Camera: Phoenix ICON (100° FOV). Wide-field fundus image from infant ROP screening — 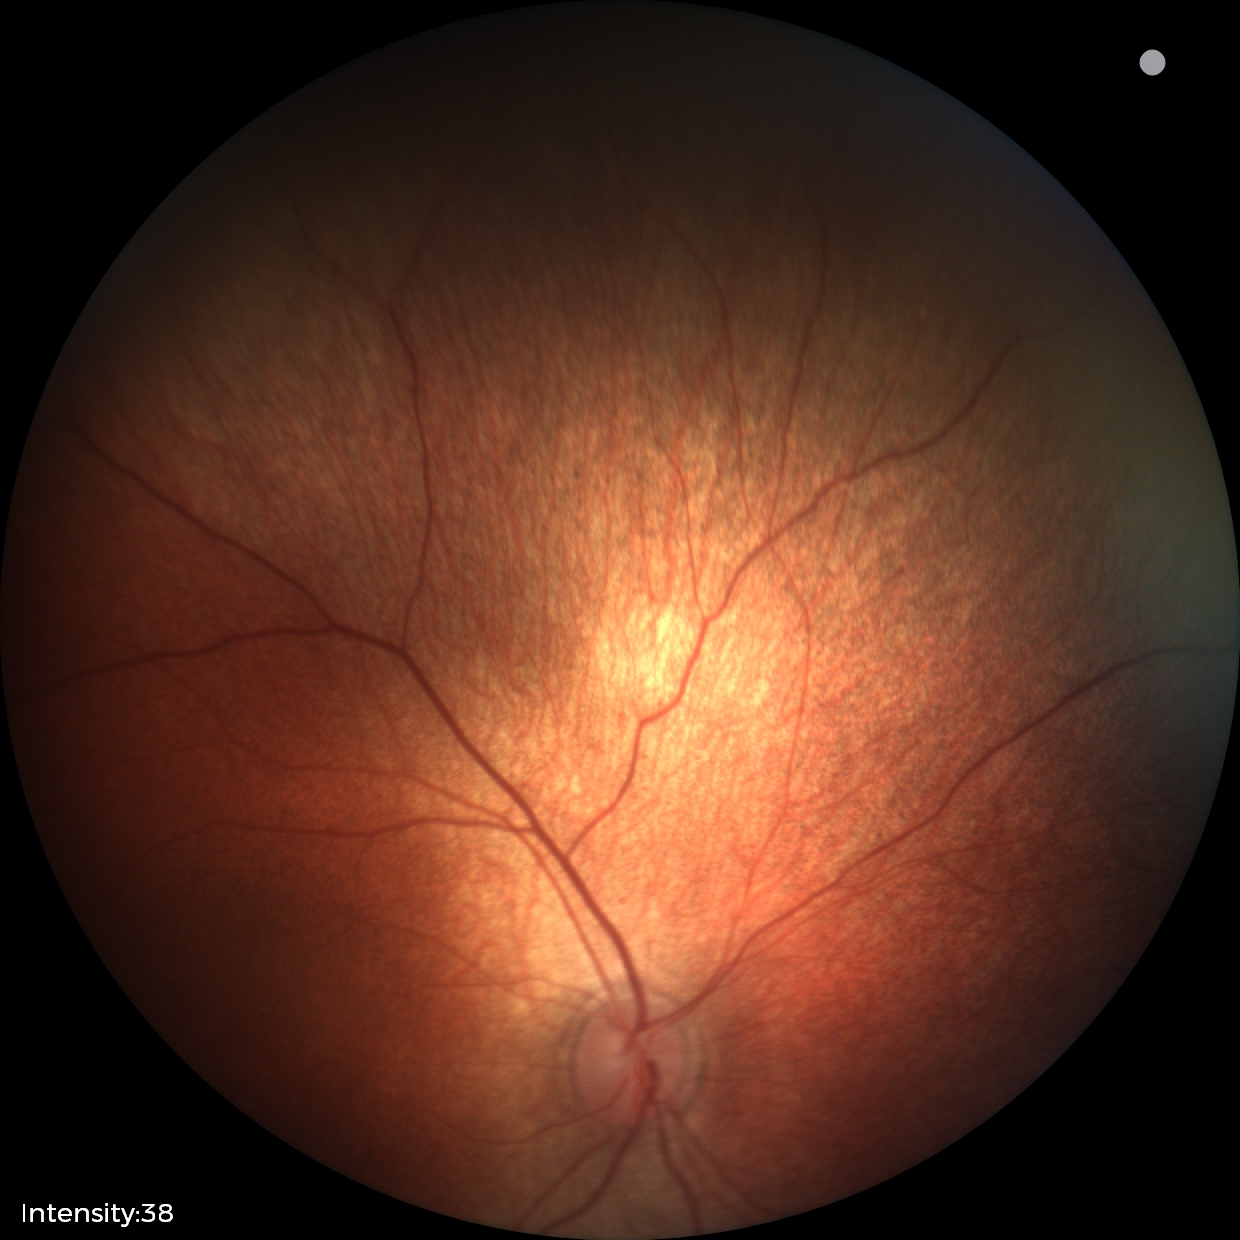

Screening examination diagnosed as physiological.